Wide-field fundus photograph from neonatal ROP screening. Captured with the Clarity RetCam 3 (130° field of view): 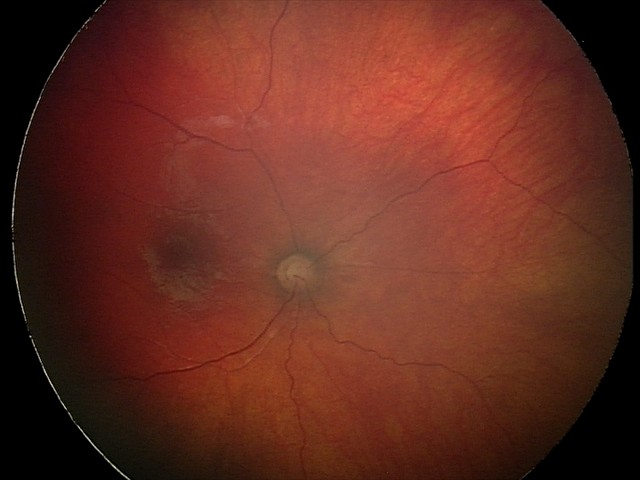 From an examination with diagnosis of optic nerve hypoplasia.